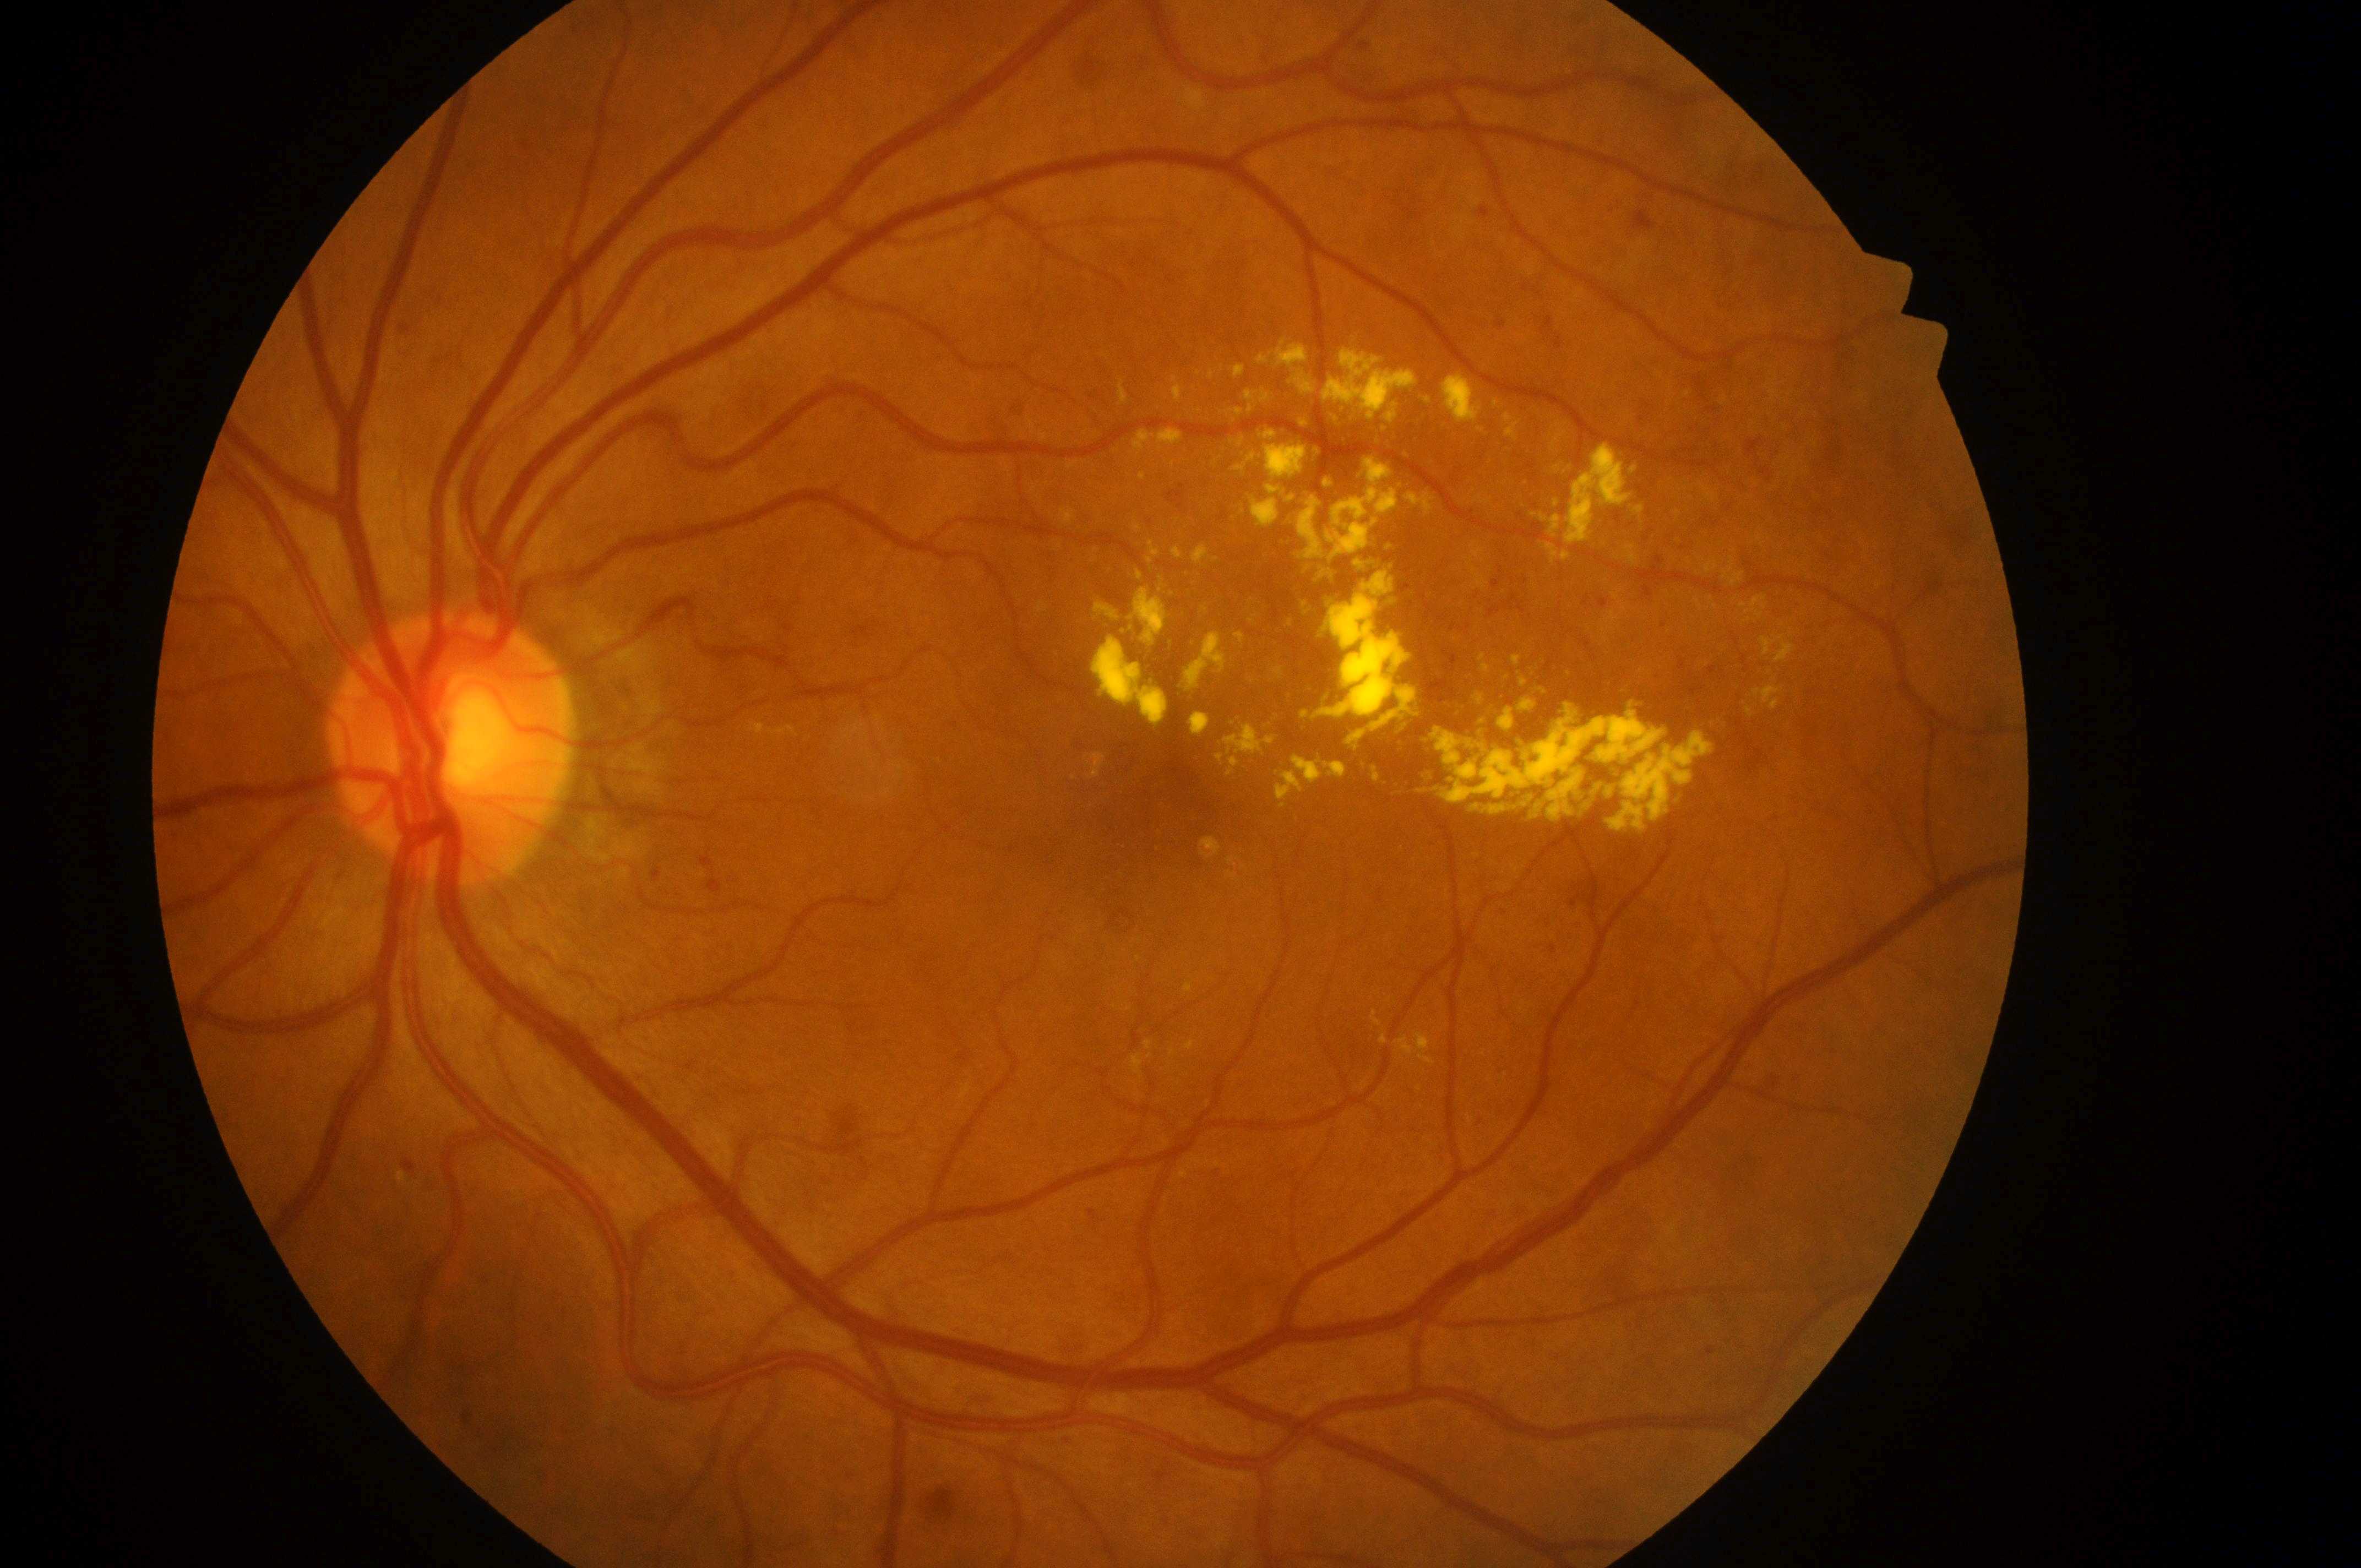
disc center@x=441, y=752 | retinopathy@moderate NPDR (grade 2) — more than just microaneurysms but less than severe NPDR | risk of diabetic macular edema@grade 2 (high risk) — hard exudates within one disc diameter of the macula center | foveal center@x=1163, y=816 | left eye.